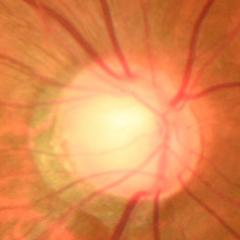 Optic disc appearance consistent with early glaucoma.